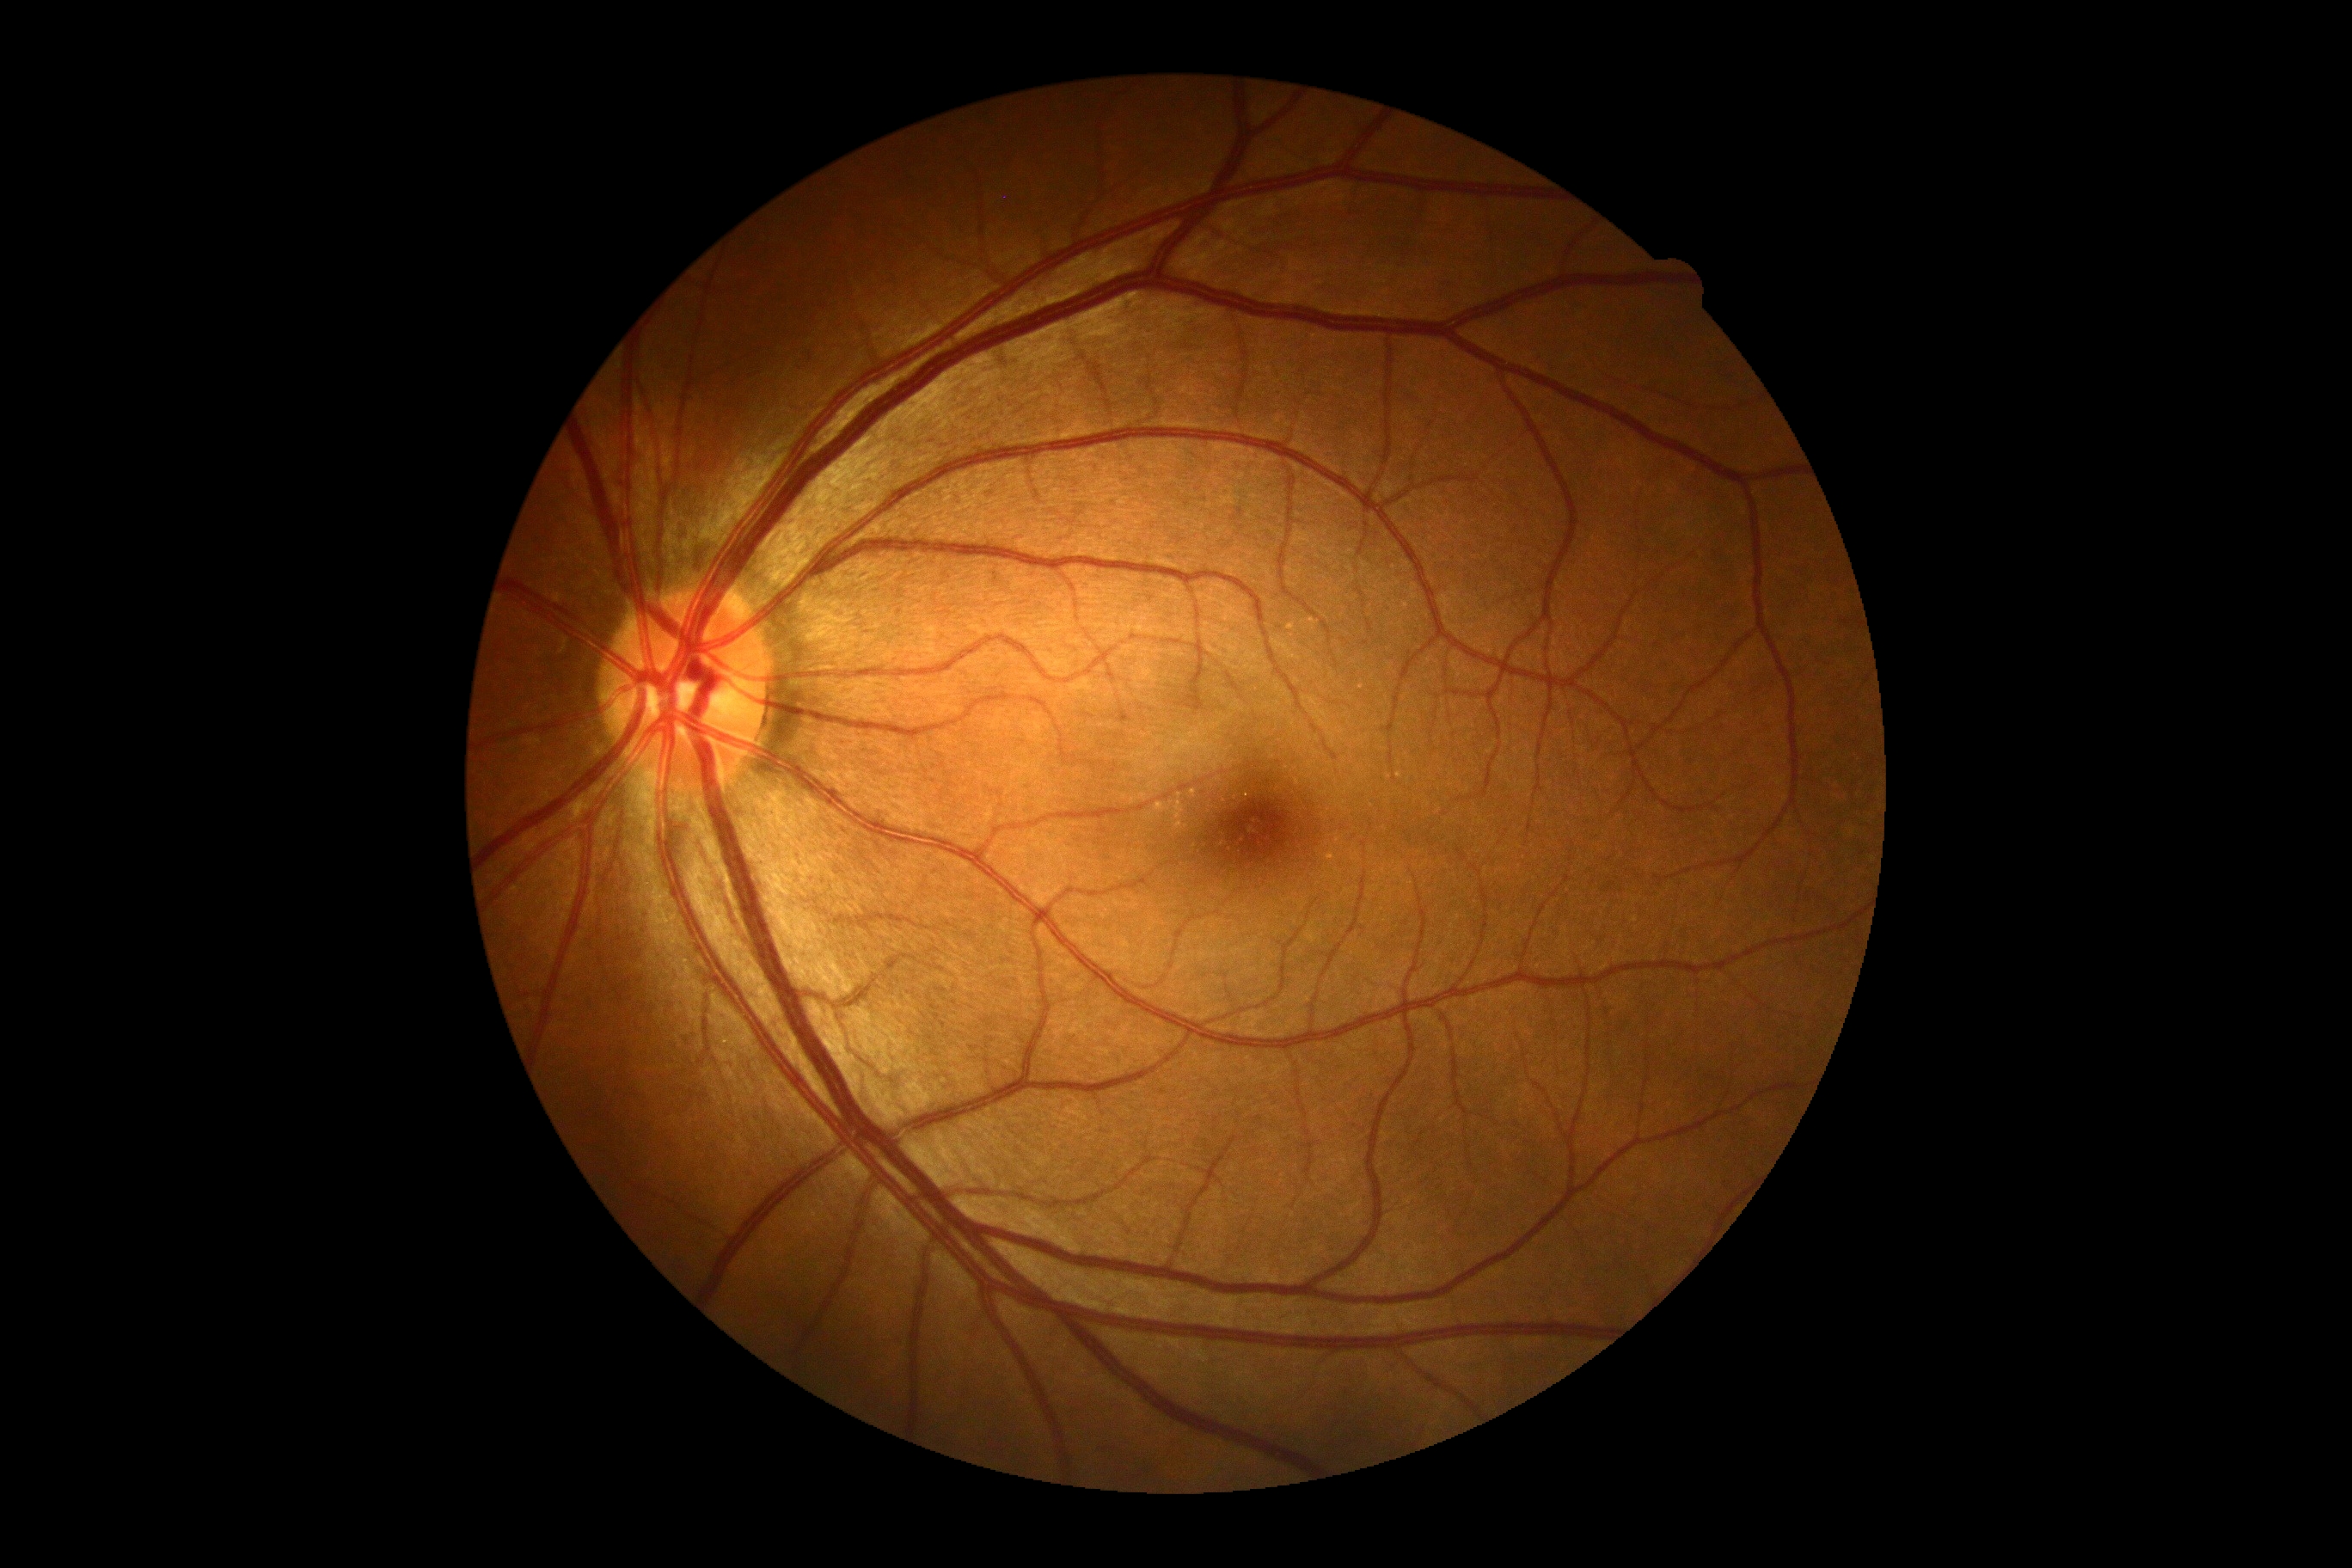 Annotations:
- diabetic retinopathy (DR) — grade 0